Image size 1659x2212 — 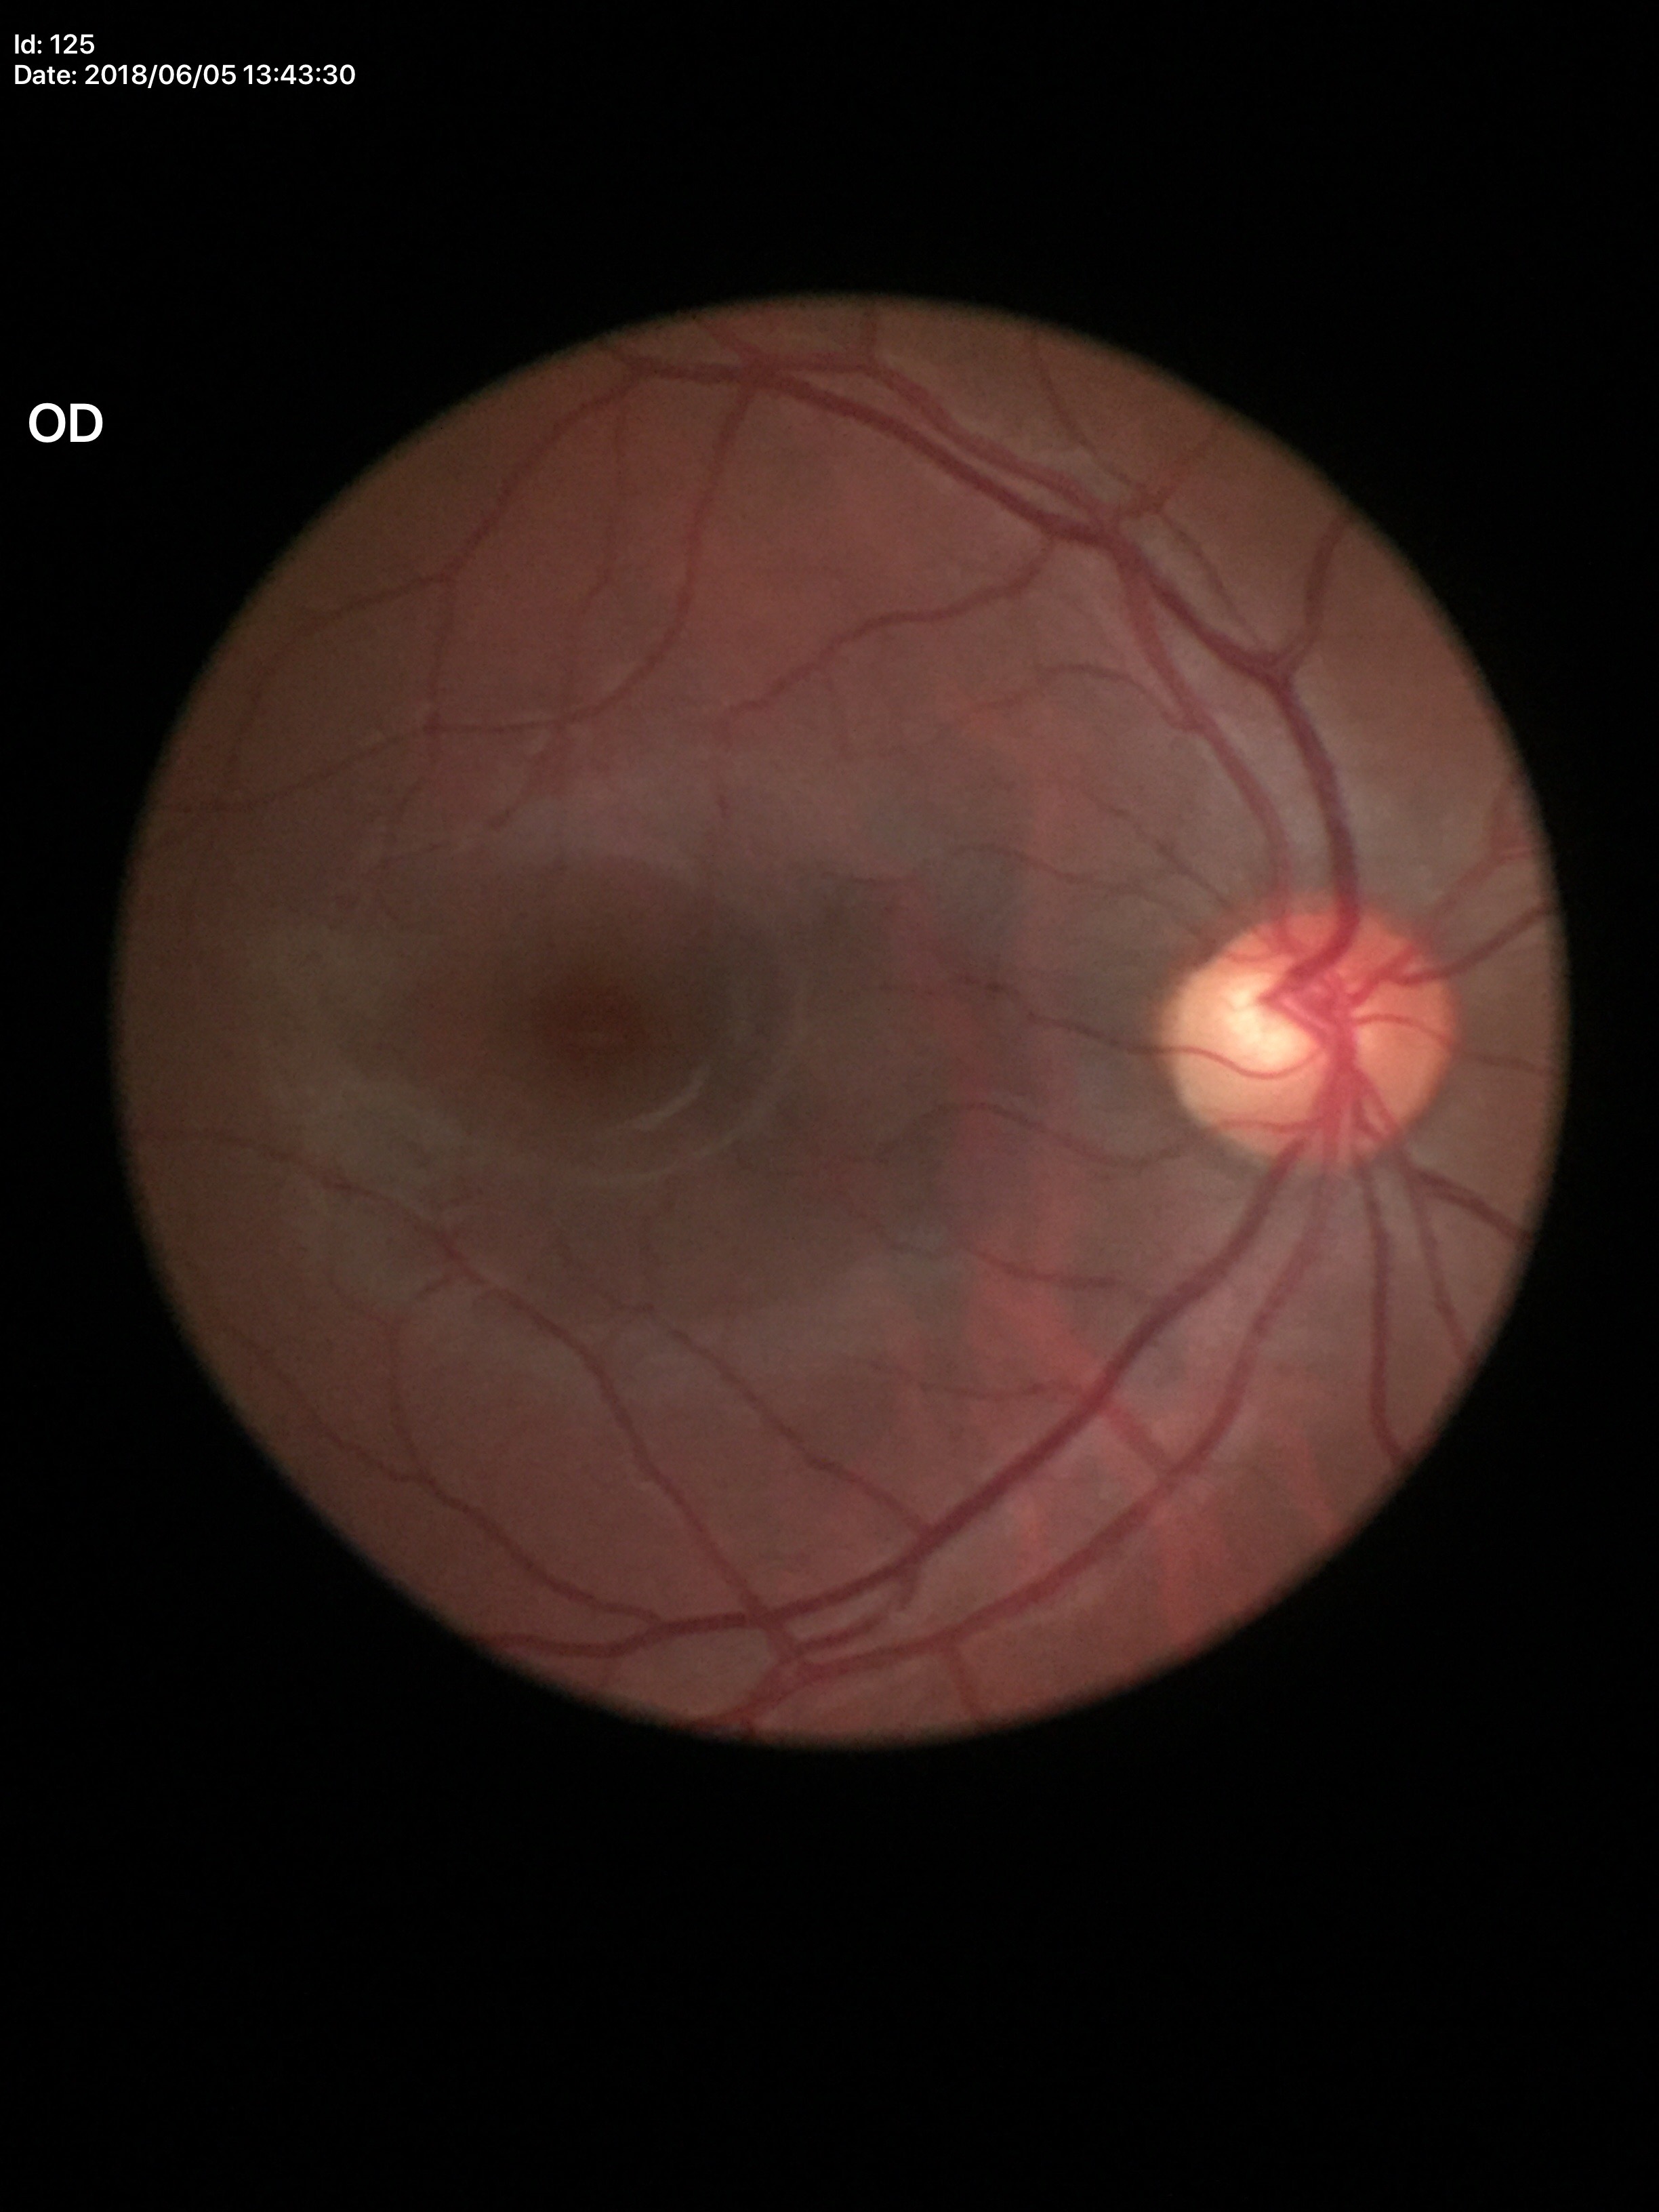 Horizontal C/D ratio (HCDR) of 0.56.
Glaucoma evaluation: not suspect (one of five ophthalmologists flagged glaucoma suspect).
Vertical cup-to-disc ratio (VCDR) is 0.58.